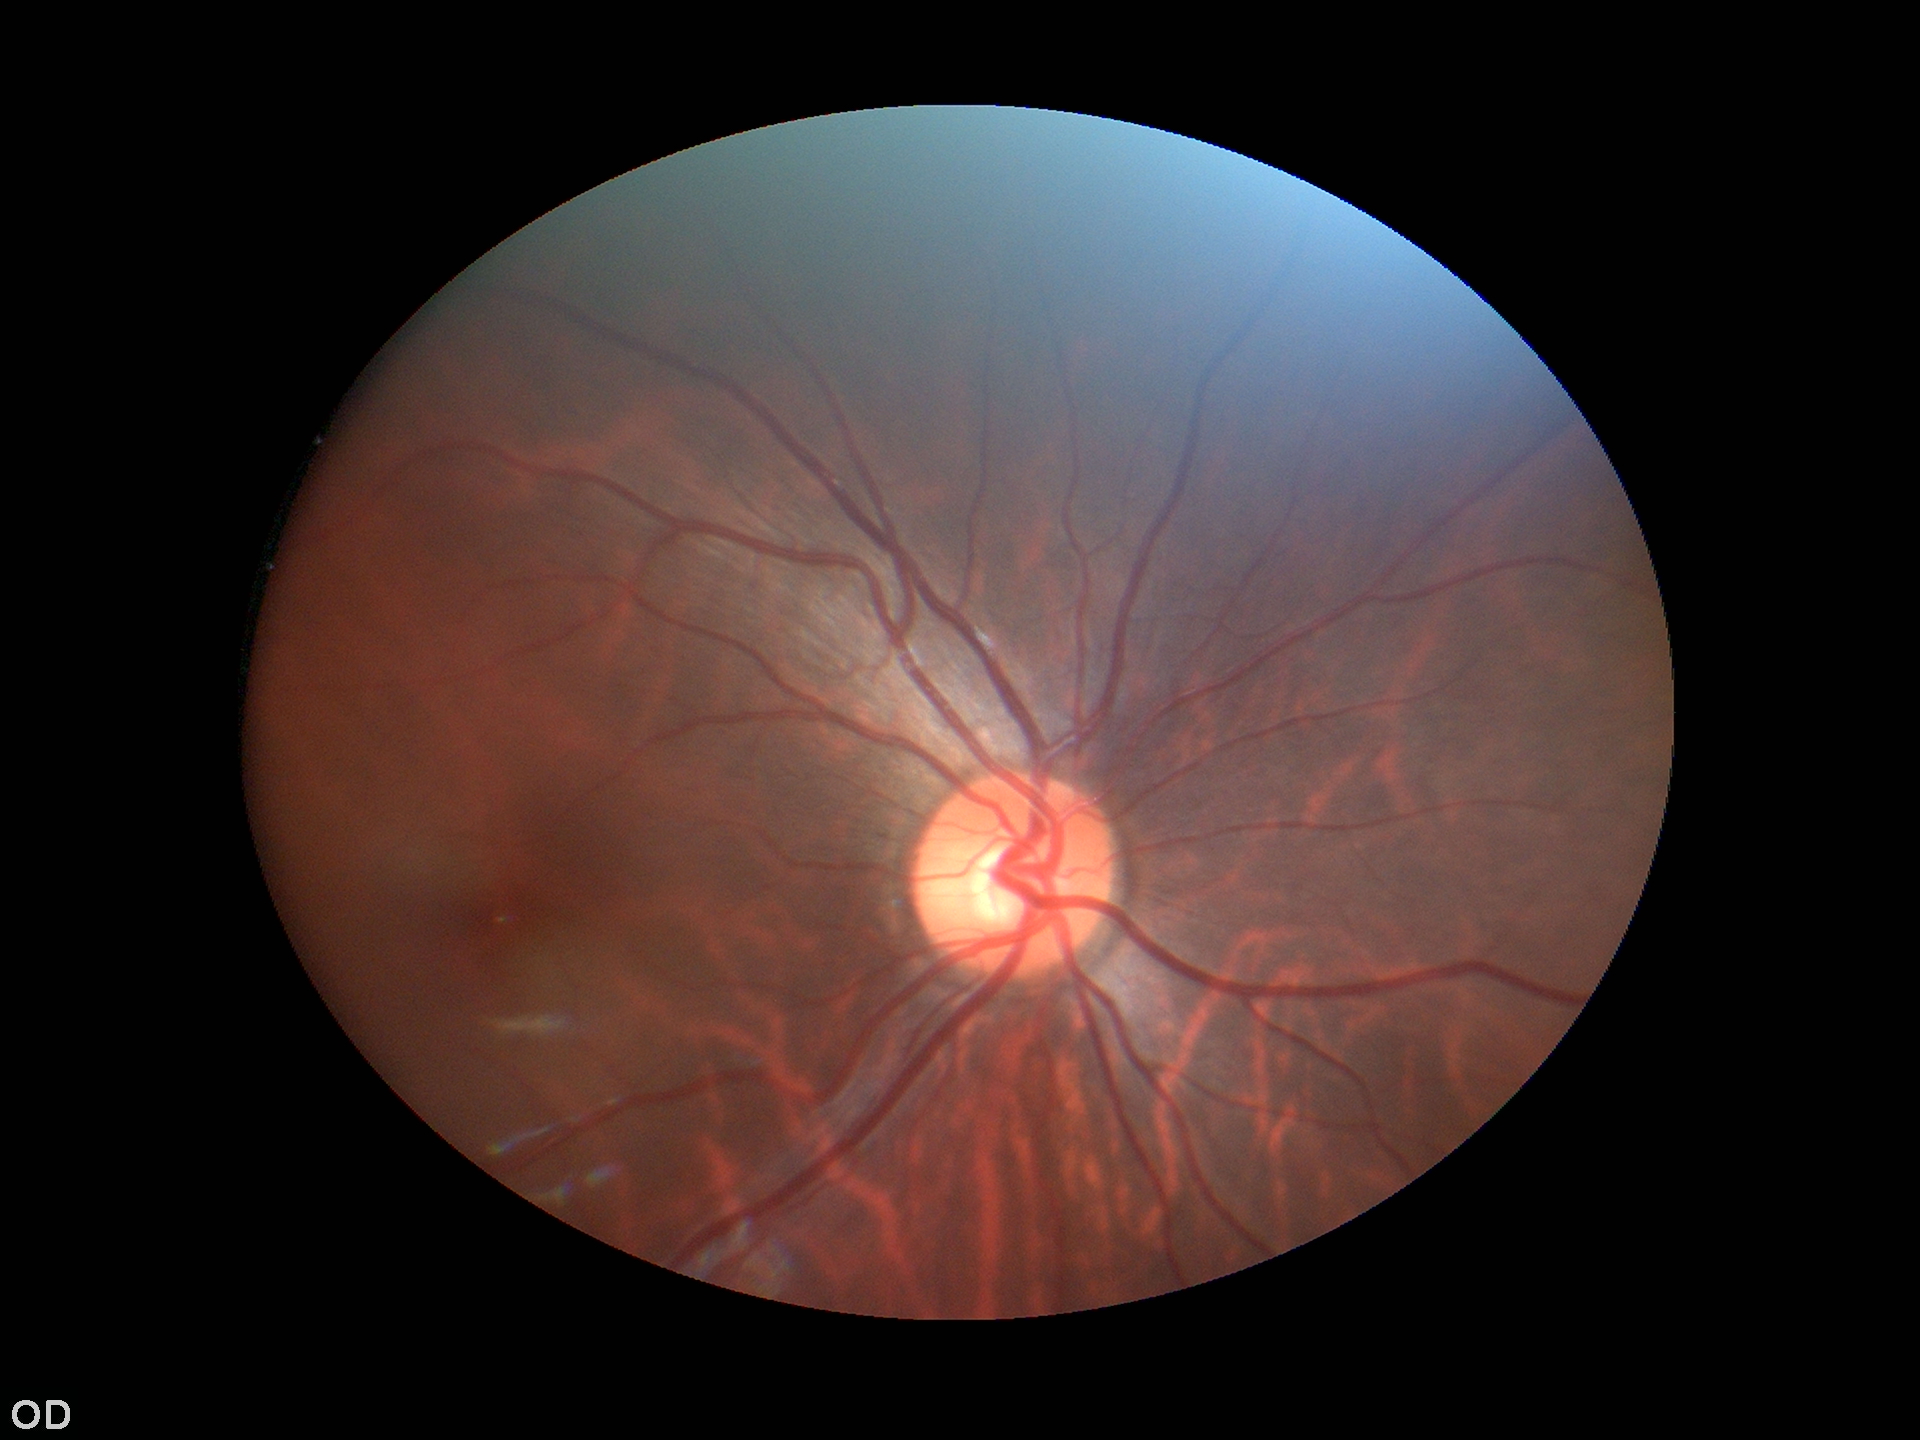
No evidence of glaucoma (all 5 graders called normal).
Horizontal CDR (HCDR): 0.53.
Vertical CDR (VCDR) is 0.54.